Diabetic retinopathy graded by the modified Davis classification · acquired with a NIDEK AFC-230: 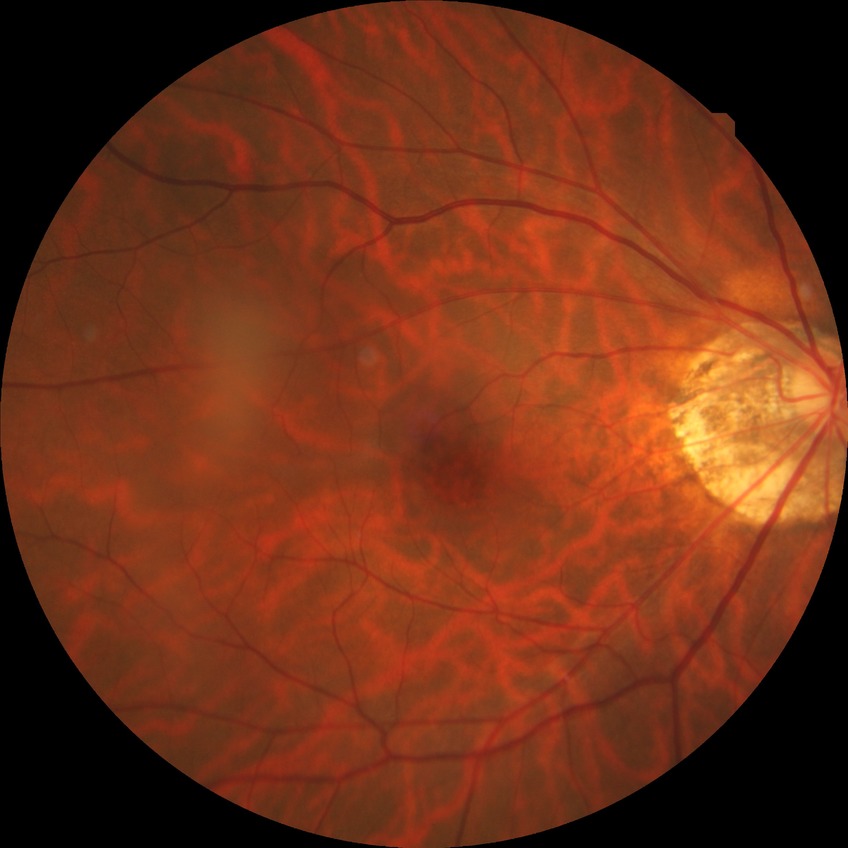
Diabetic retinopathy grade is no diabetic retinopathy.